2352 x 1568 pixels. 45° field of view. Fundus photo:
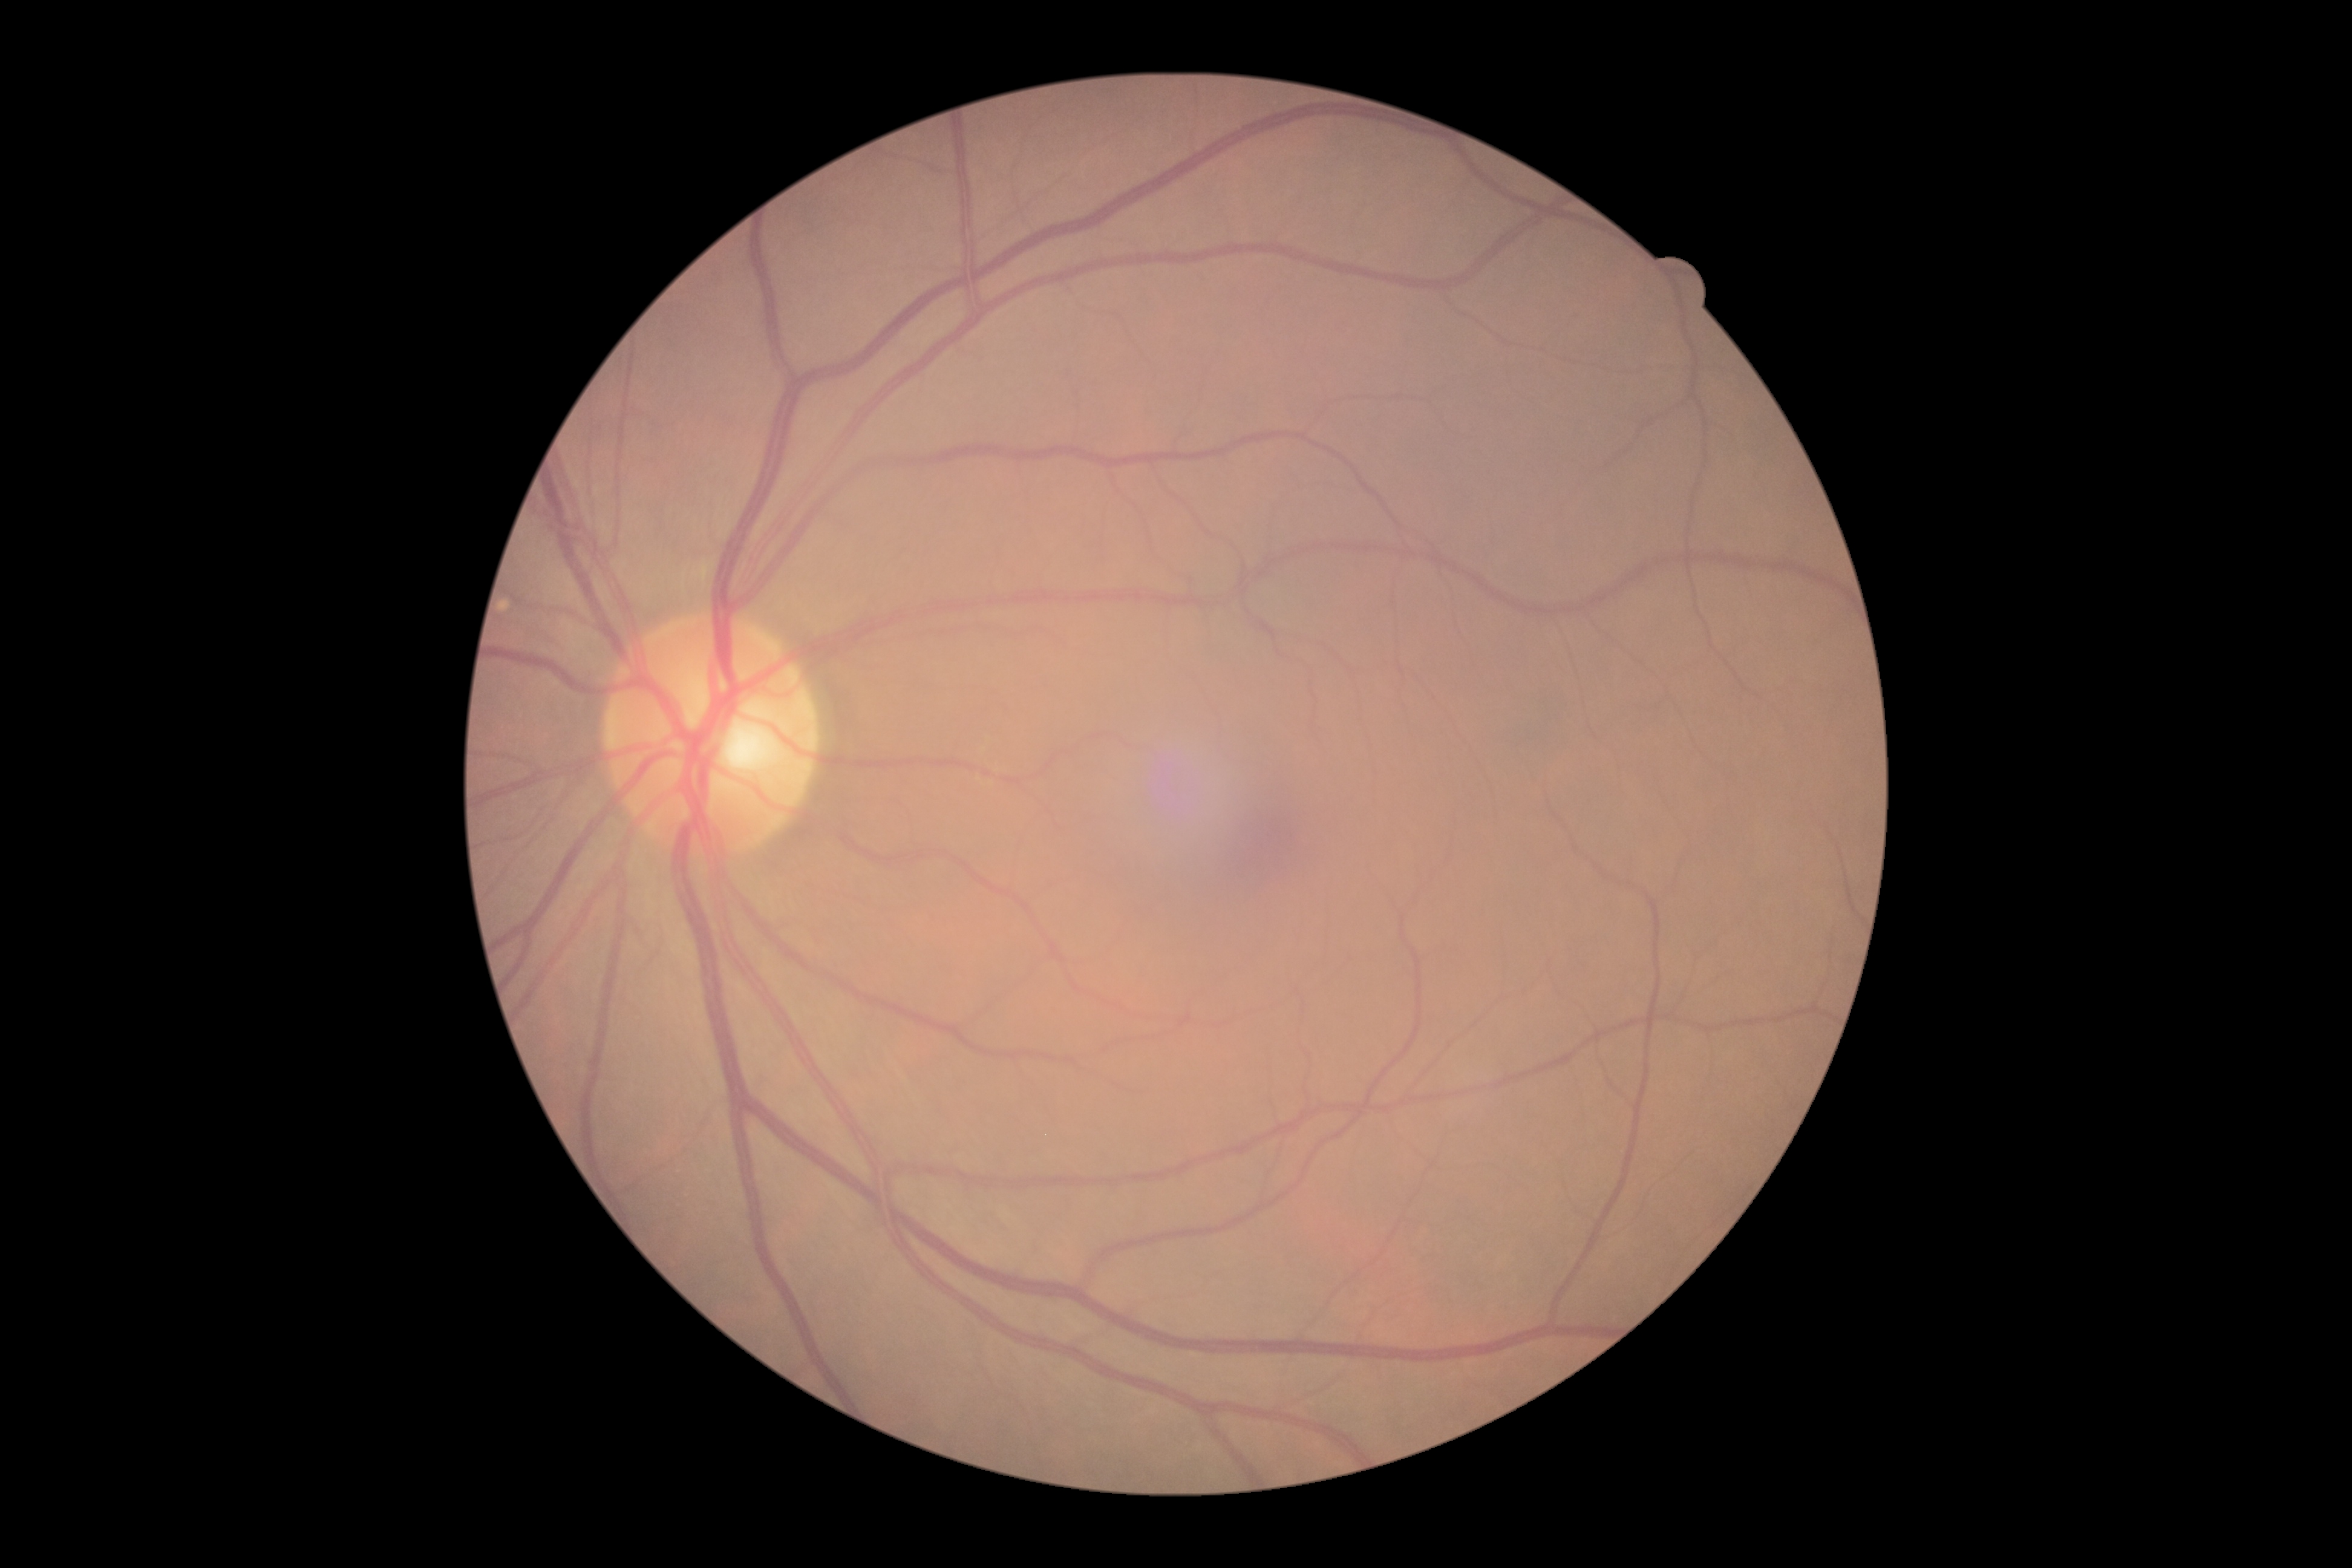
Diabetic retinopathy (DR): grade 0 (no apparent retinopathy).